Color fundus photograph.
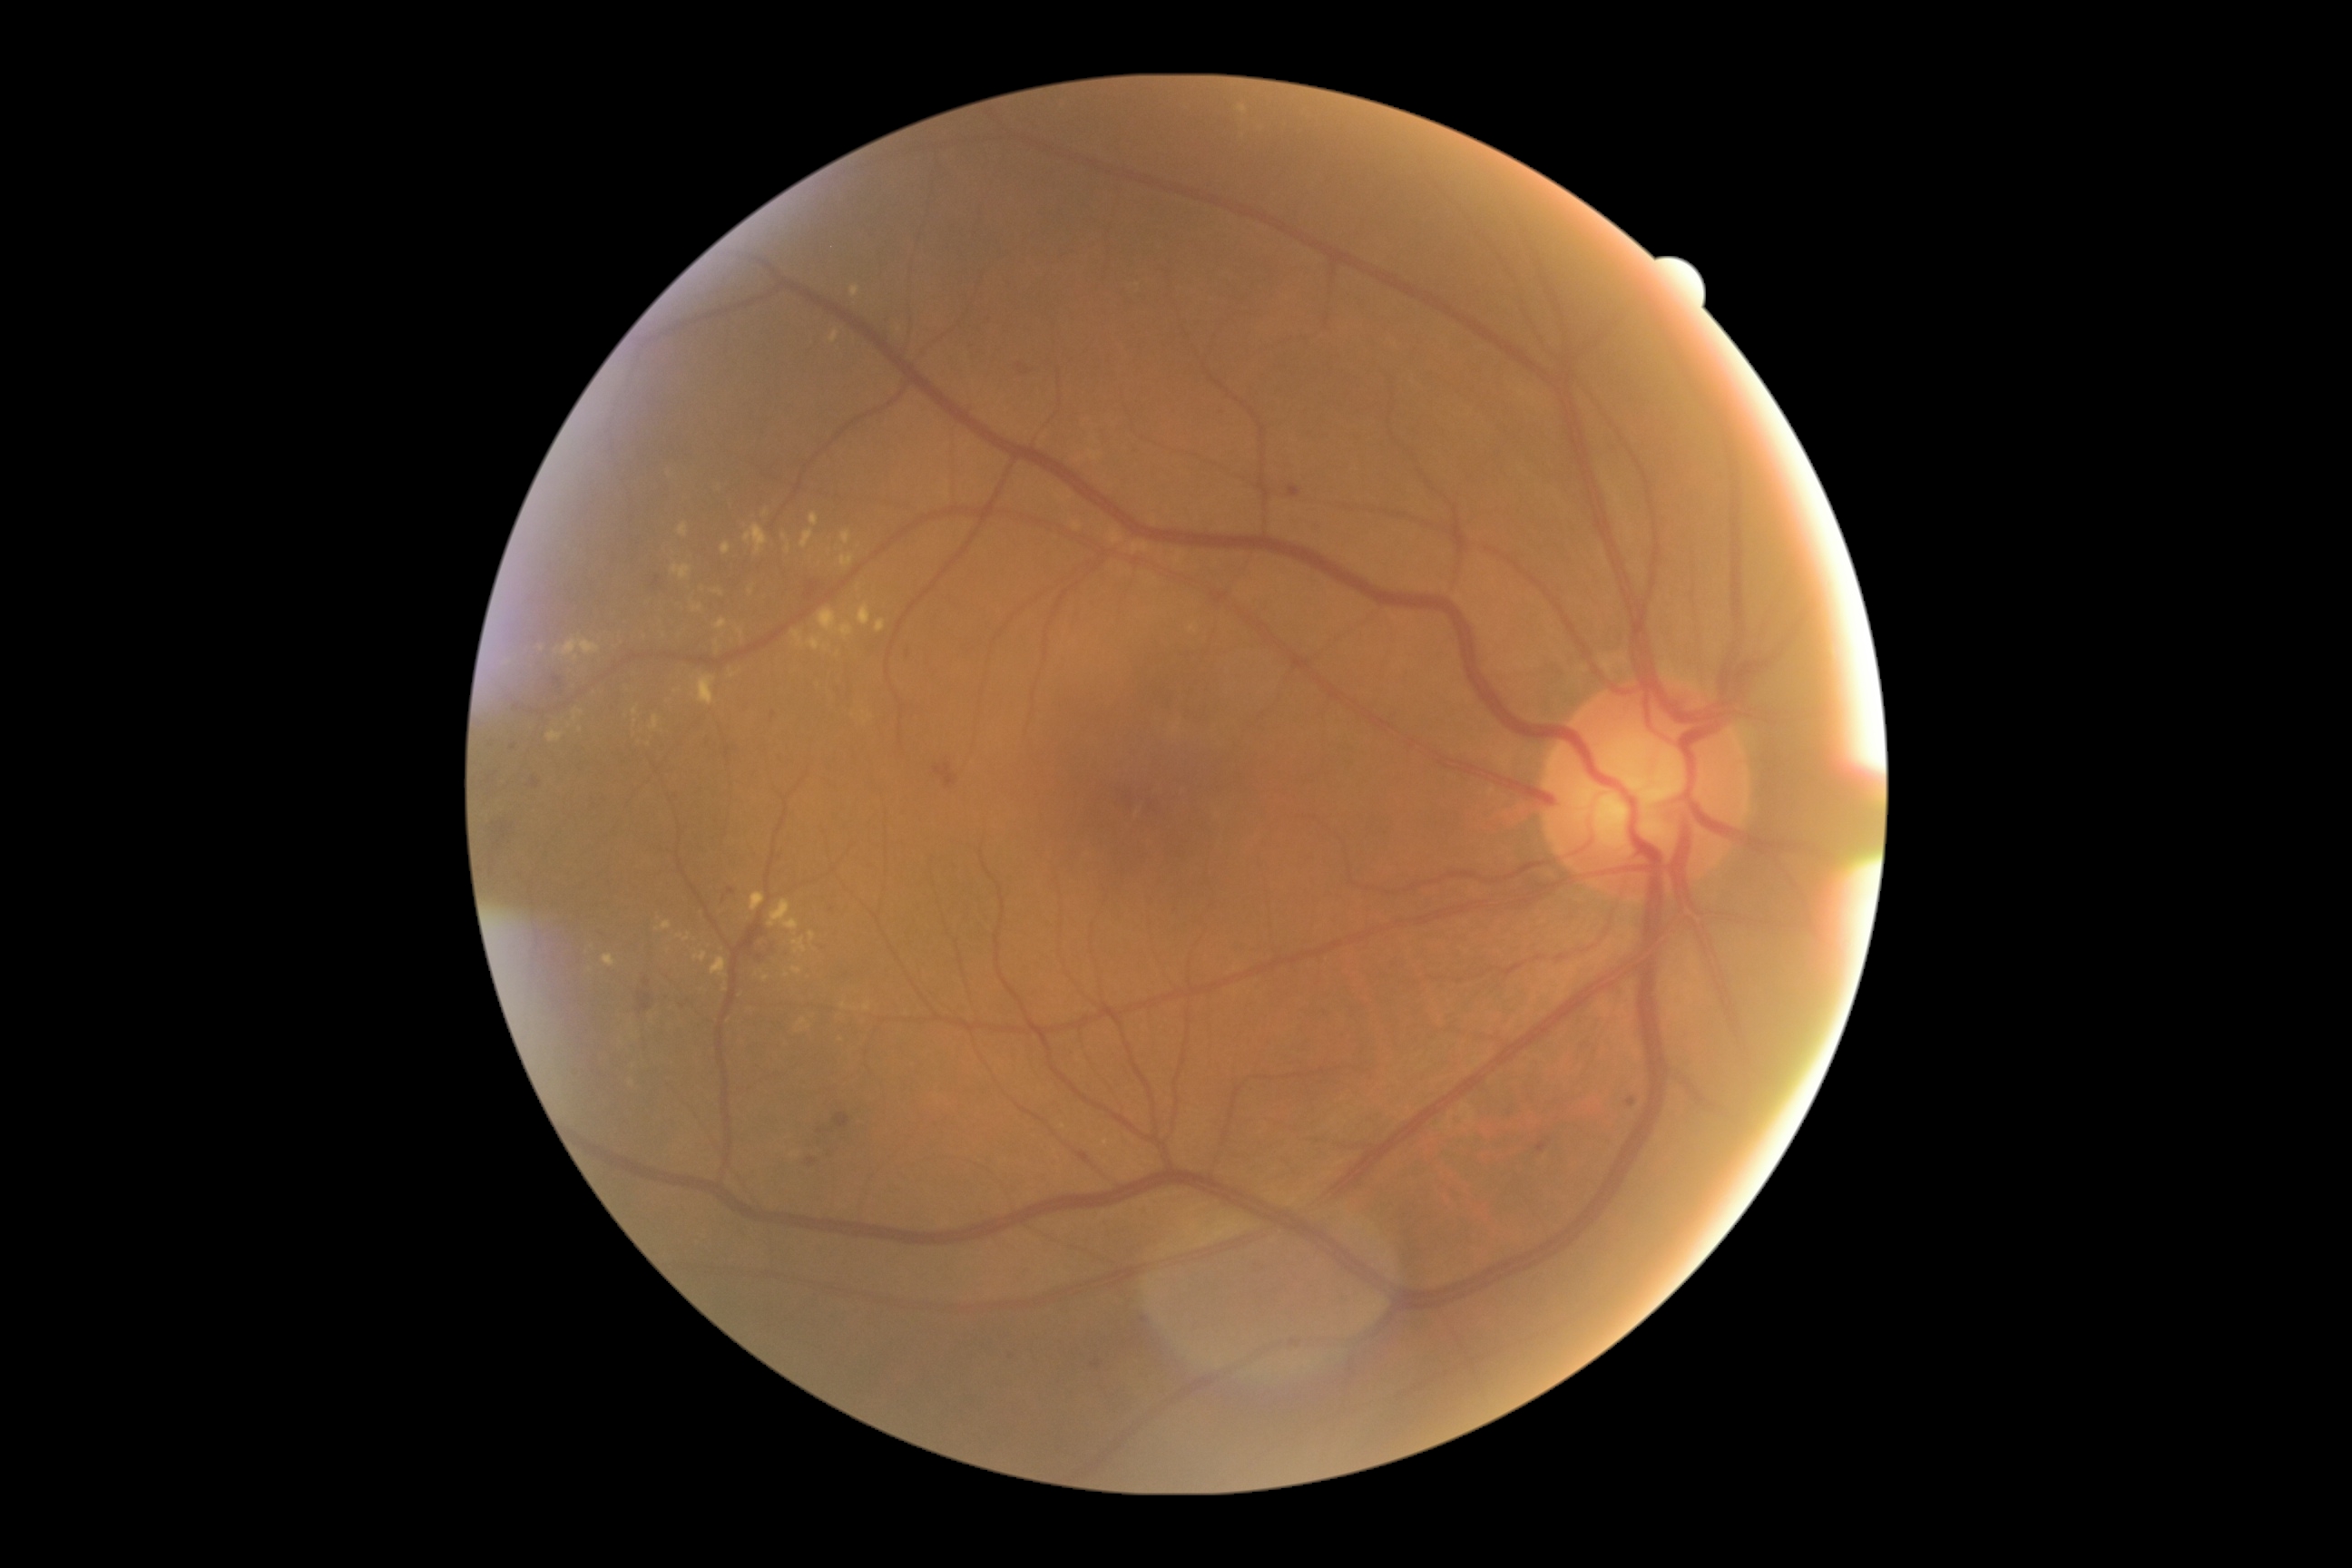
Diabetic retinopathy: grade 2 (moderate NPDR). Hard exudates include lesions at 792,939,807,954; 672,565,691,580; 564,640,600,656; 839,554,854,567; 787,544,792,554; 721,544,732,556; 685,934,691,943; 738,629,745,638; 716,620,727,631; 819,609,838,632; 678,524,689,538. Hard exudates (small, approximate centers) near (725; 990); (635; 712); (680; 936); (1107; 1143); (787; 975); (580; 730).